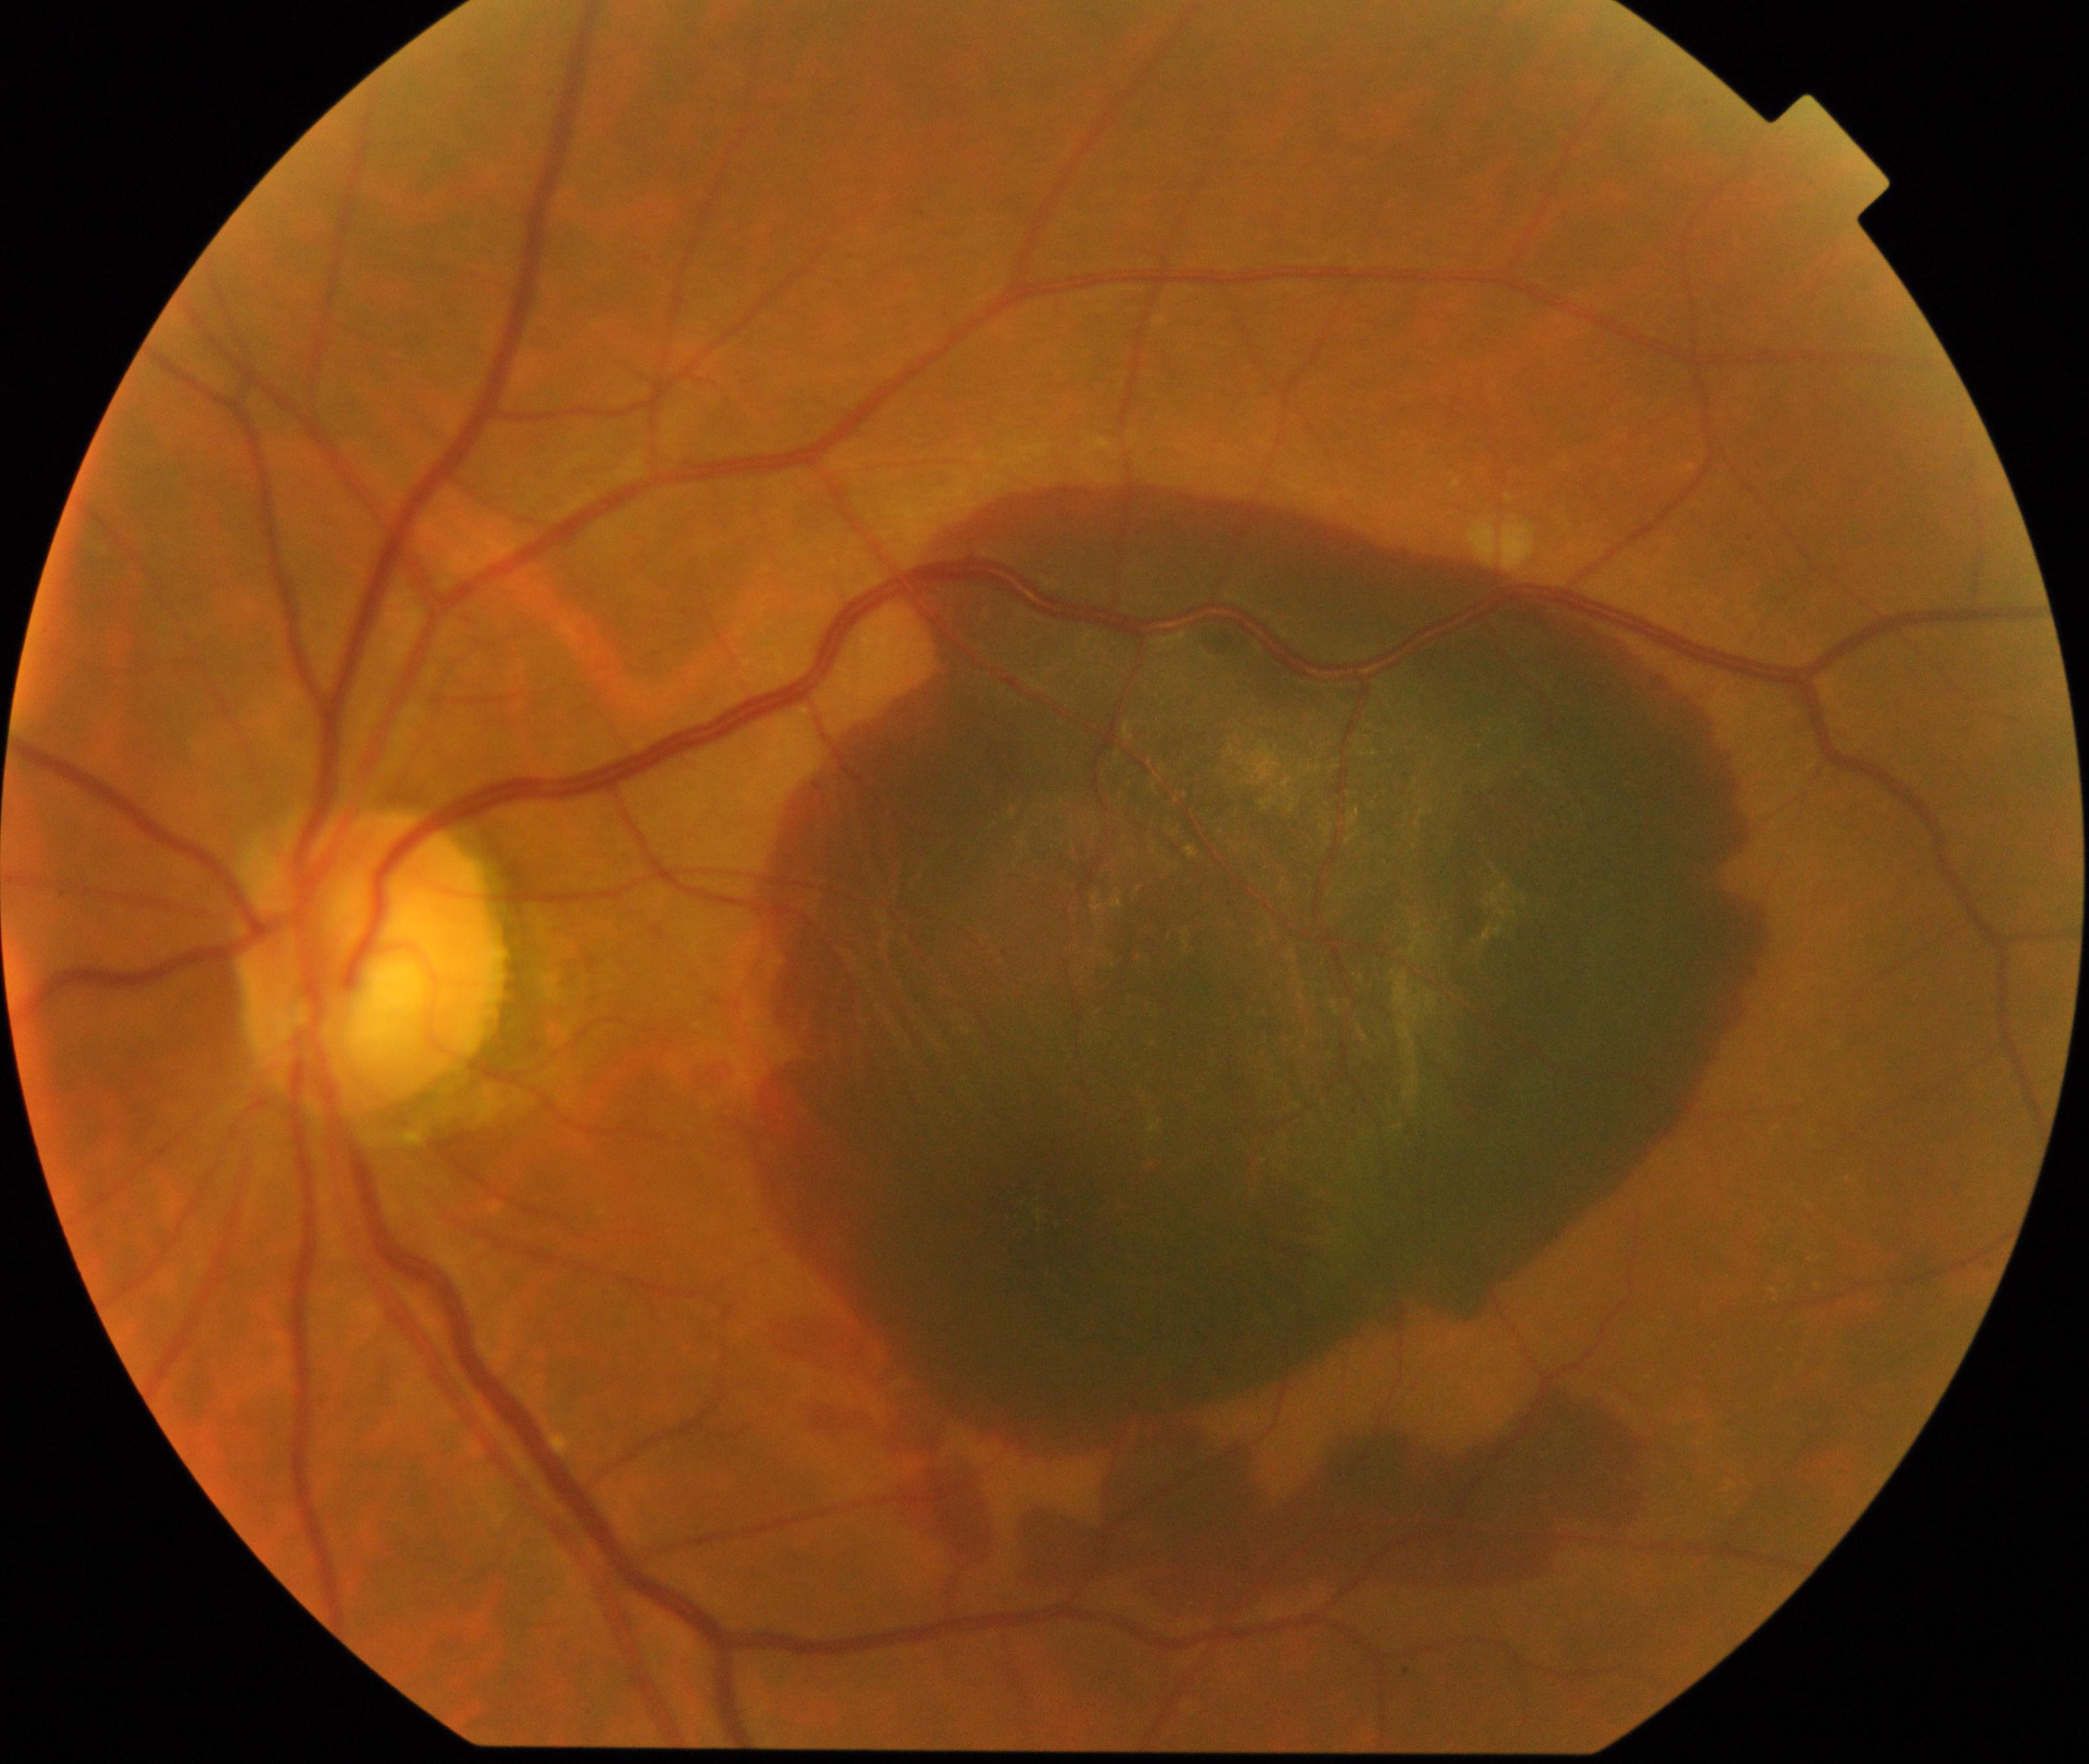 The image shows maculopathy.